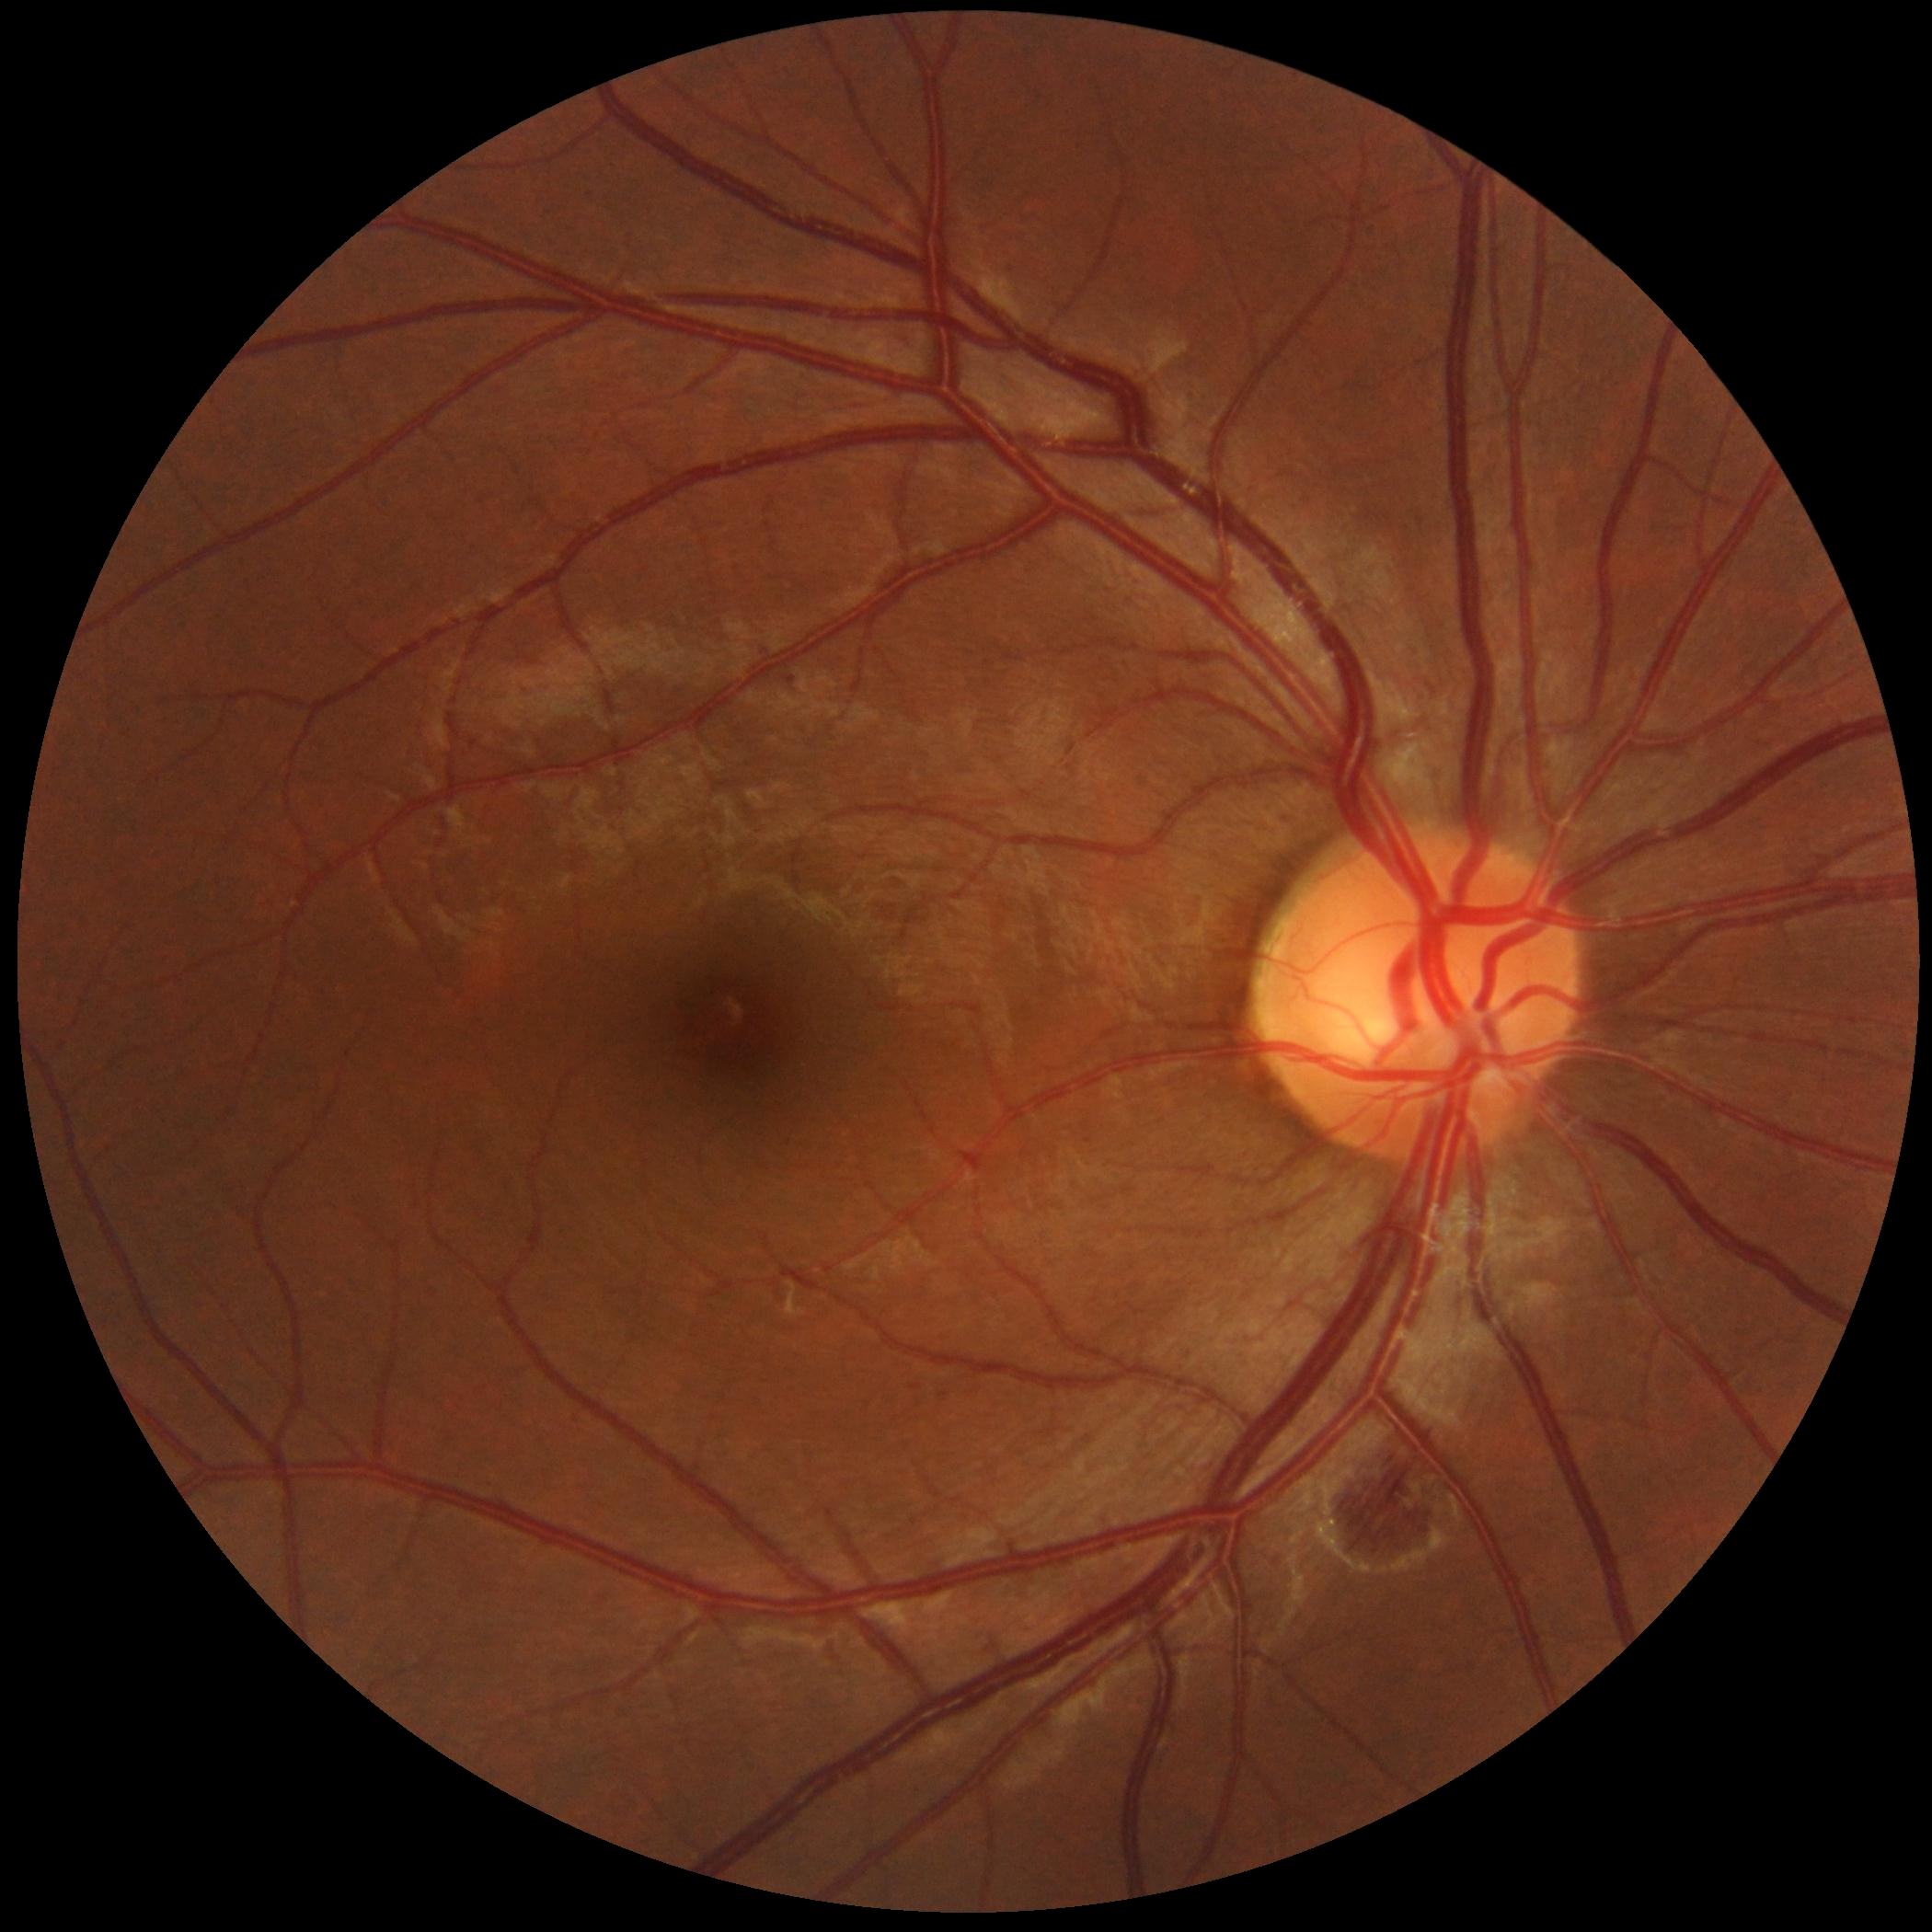

Findings:
– DR grade: 2 — more than just microaneurysms but less than severe NPDR